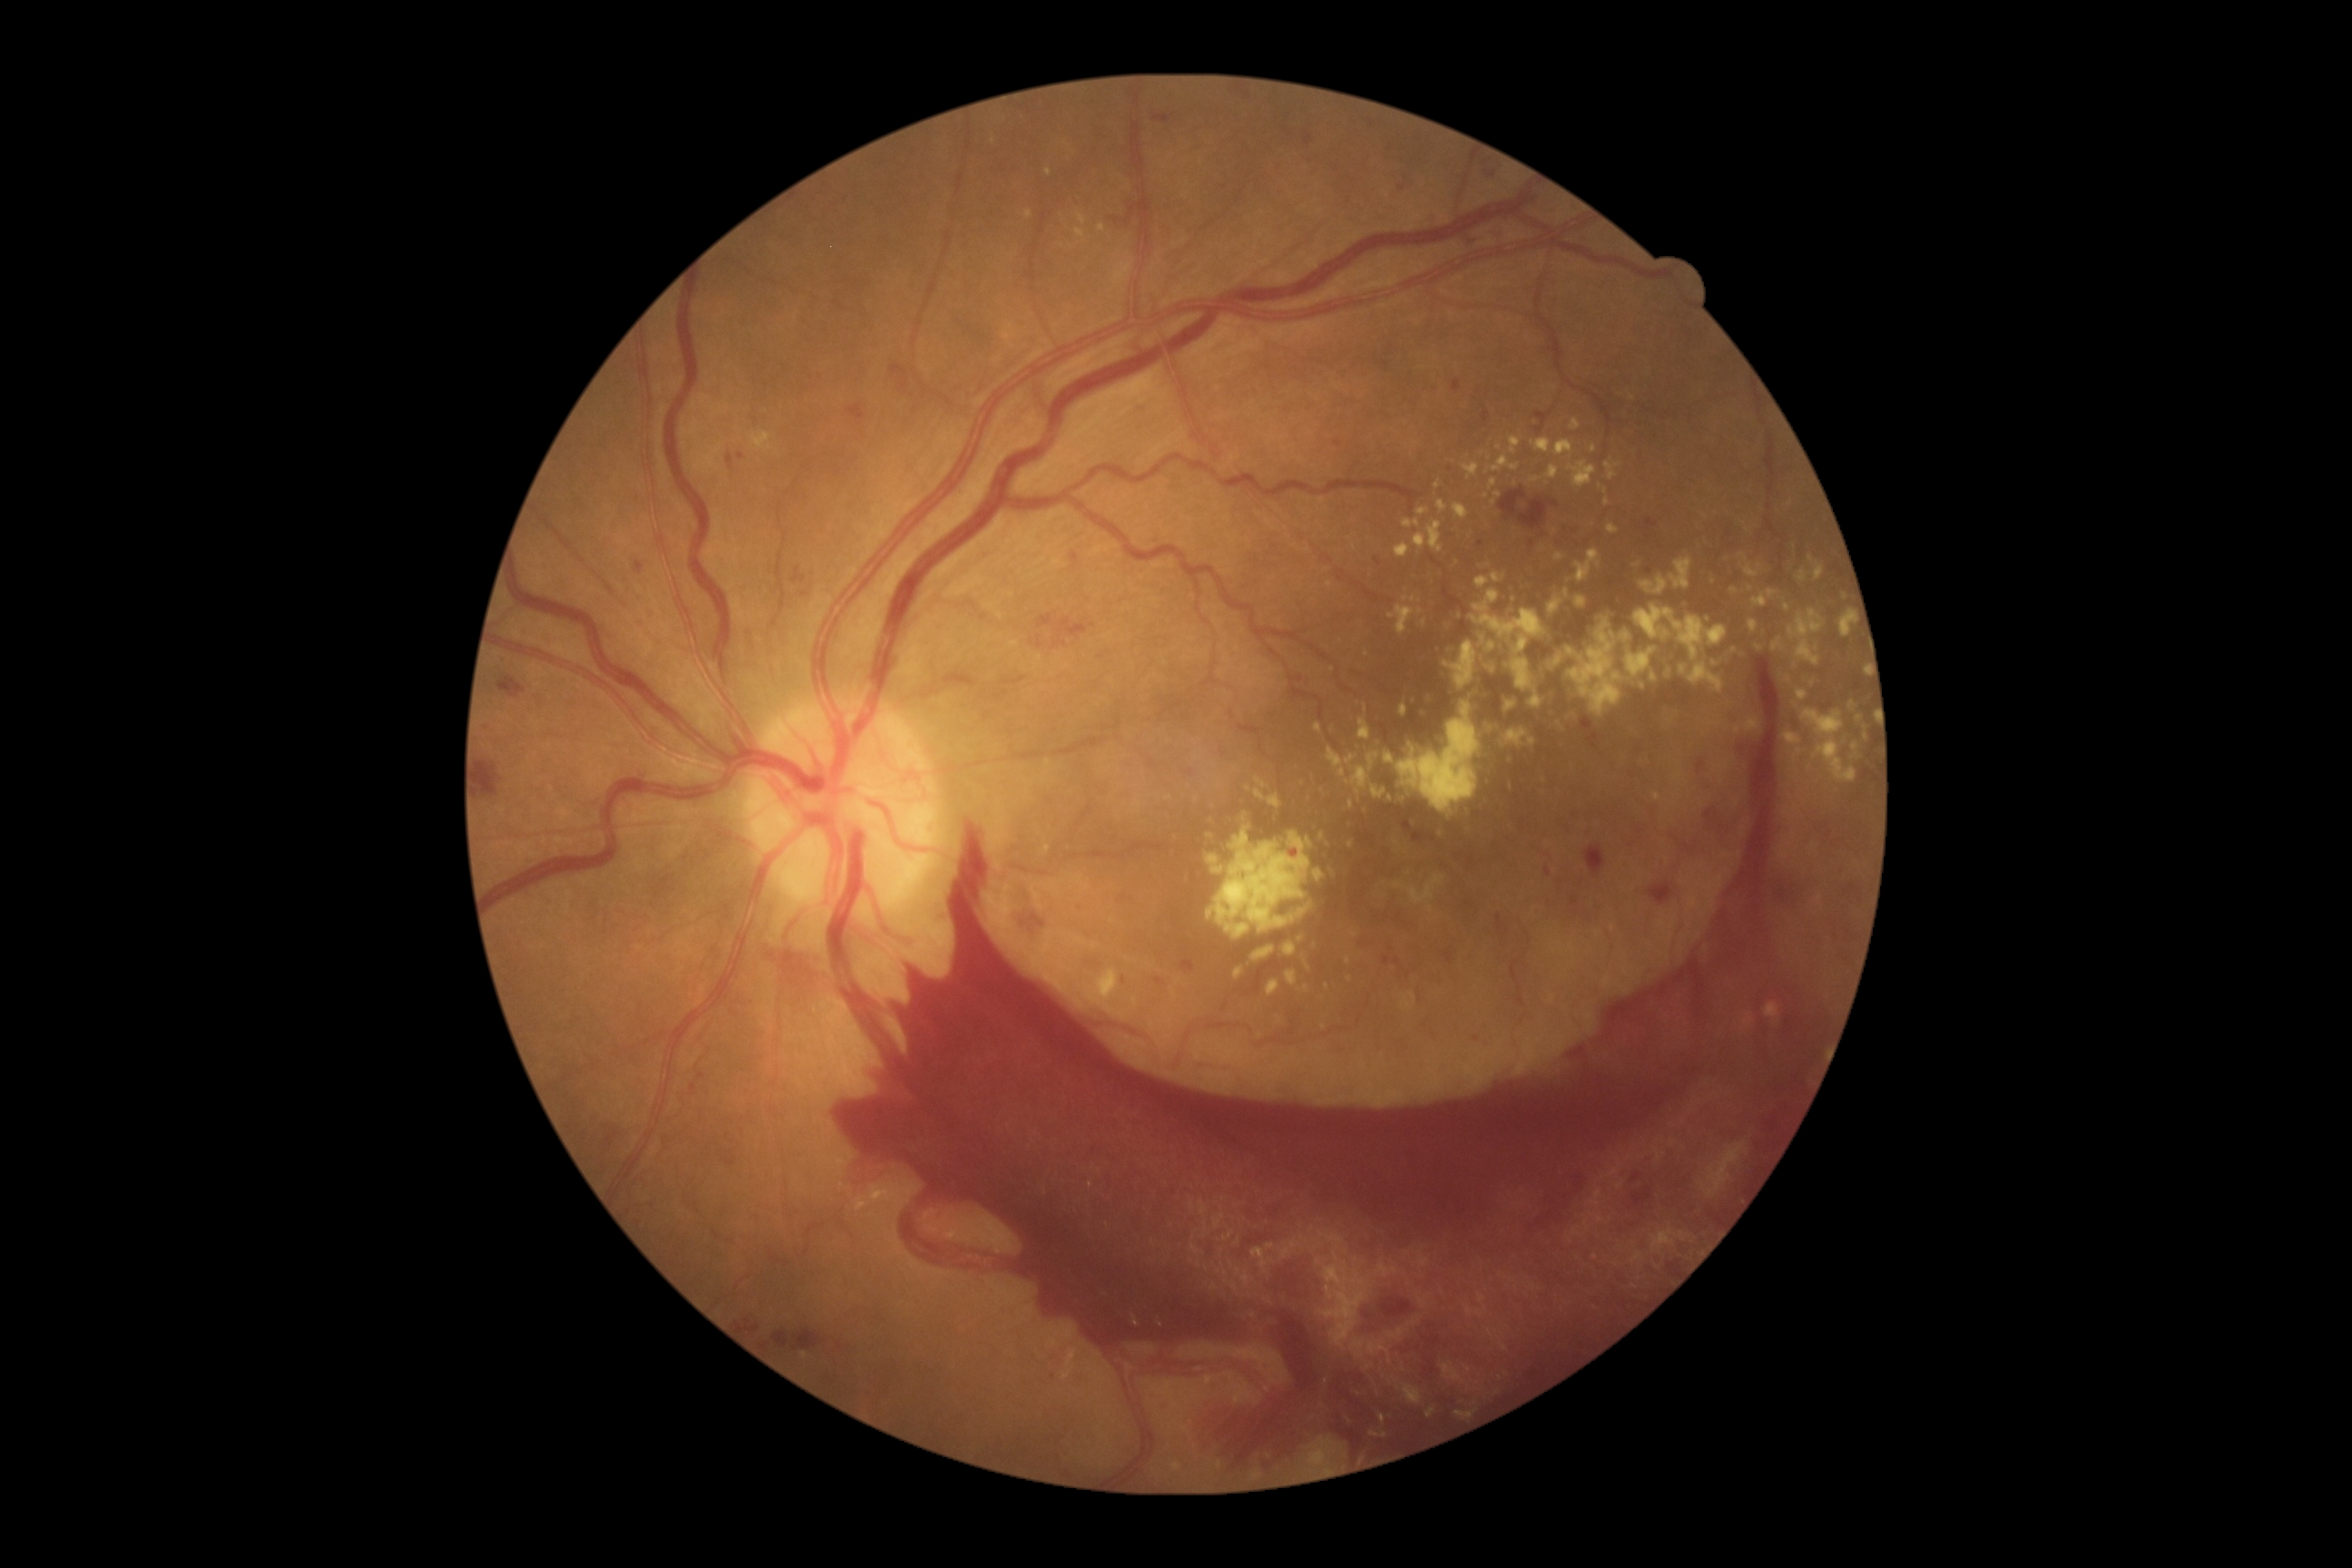 Retinopathy grade: 4 (PDR).